Nonmydriatic fundus photograph · DR severity per modified Davis staging · NIDEK AFC-230: 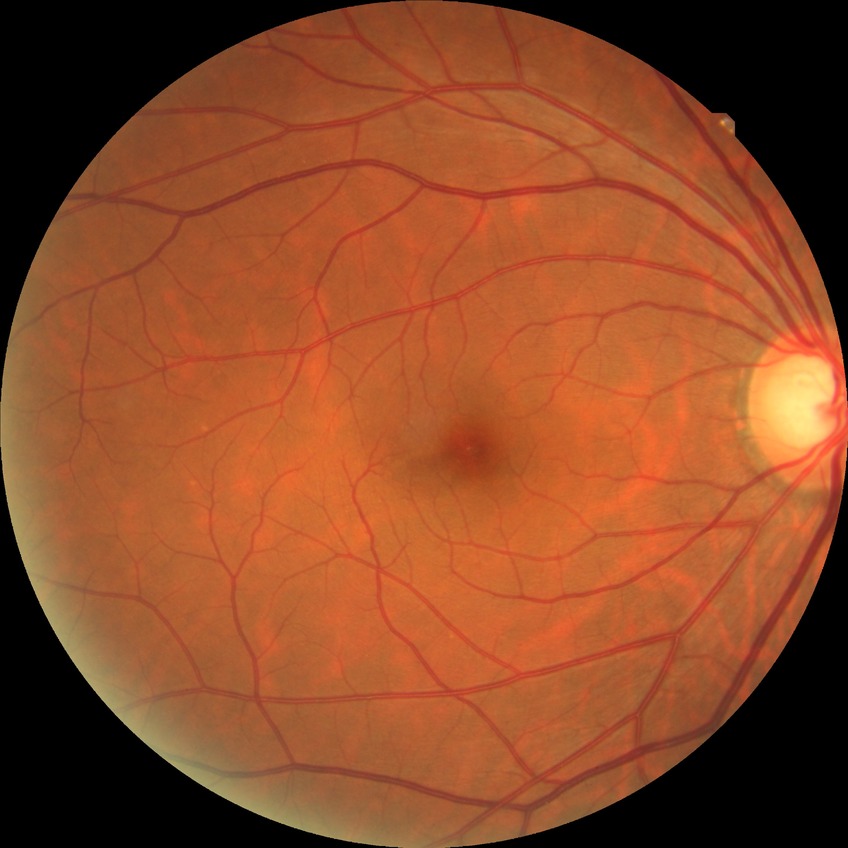 Retinopathy stage is no diabetic retinopathy.